2352 x 1568 pixels:
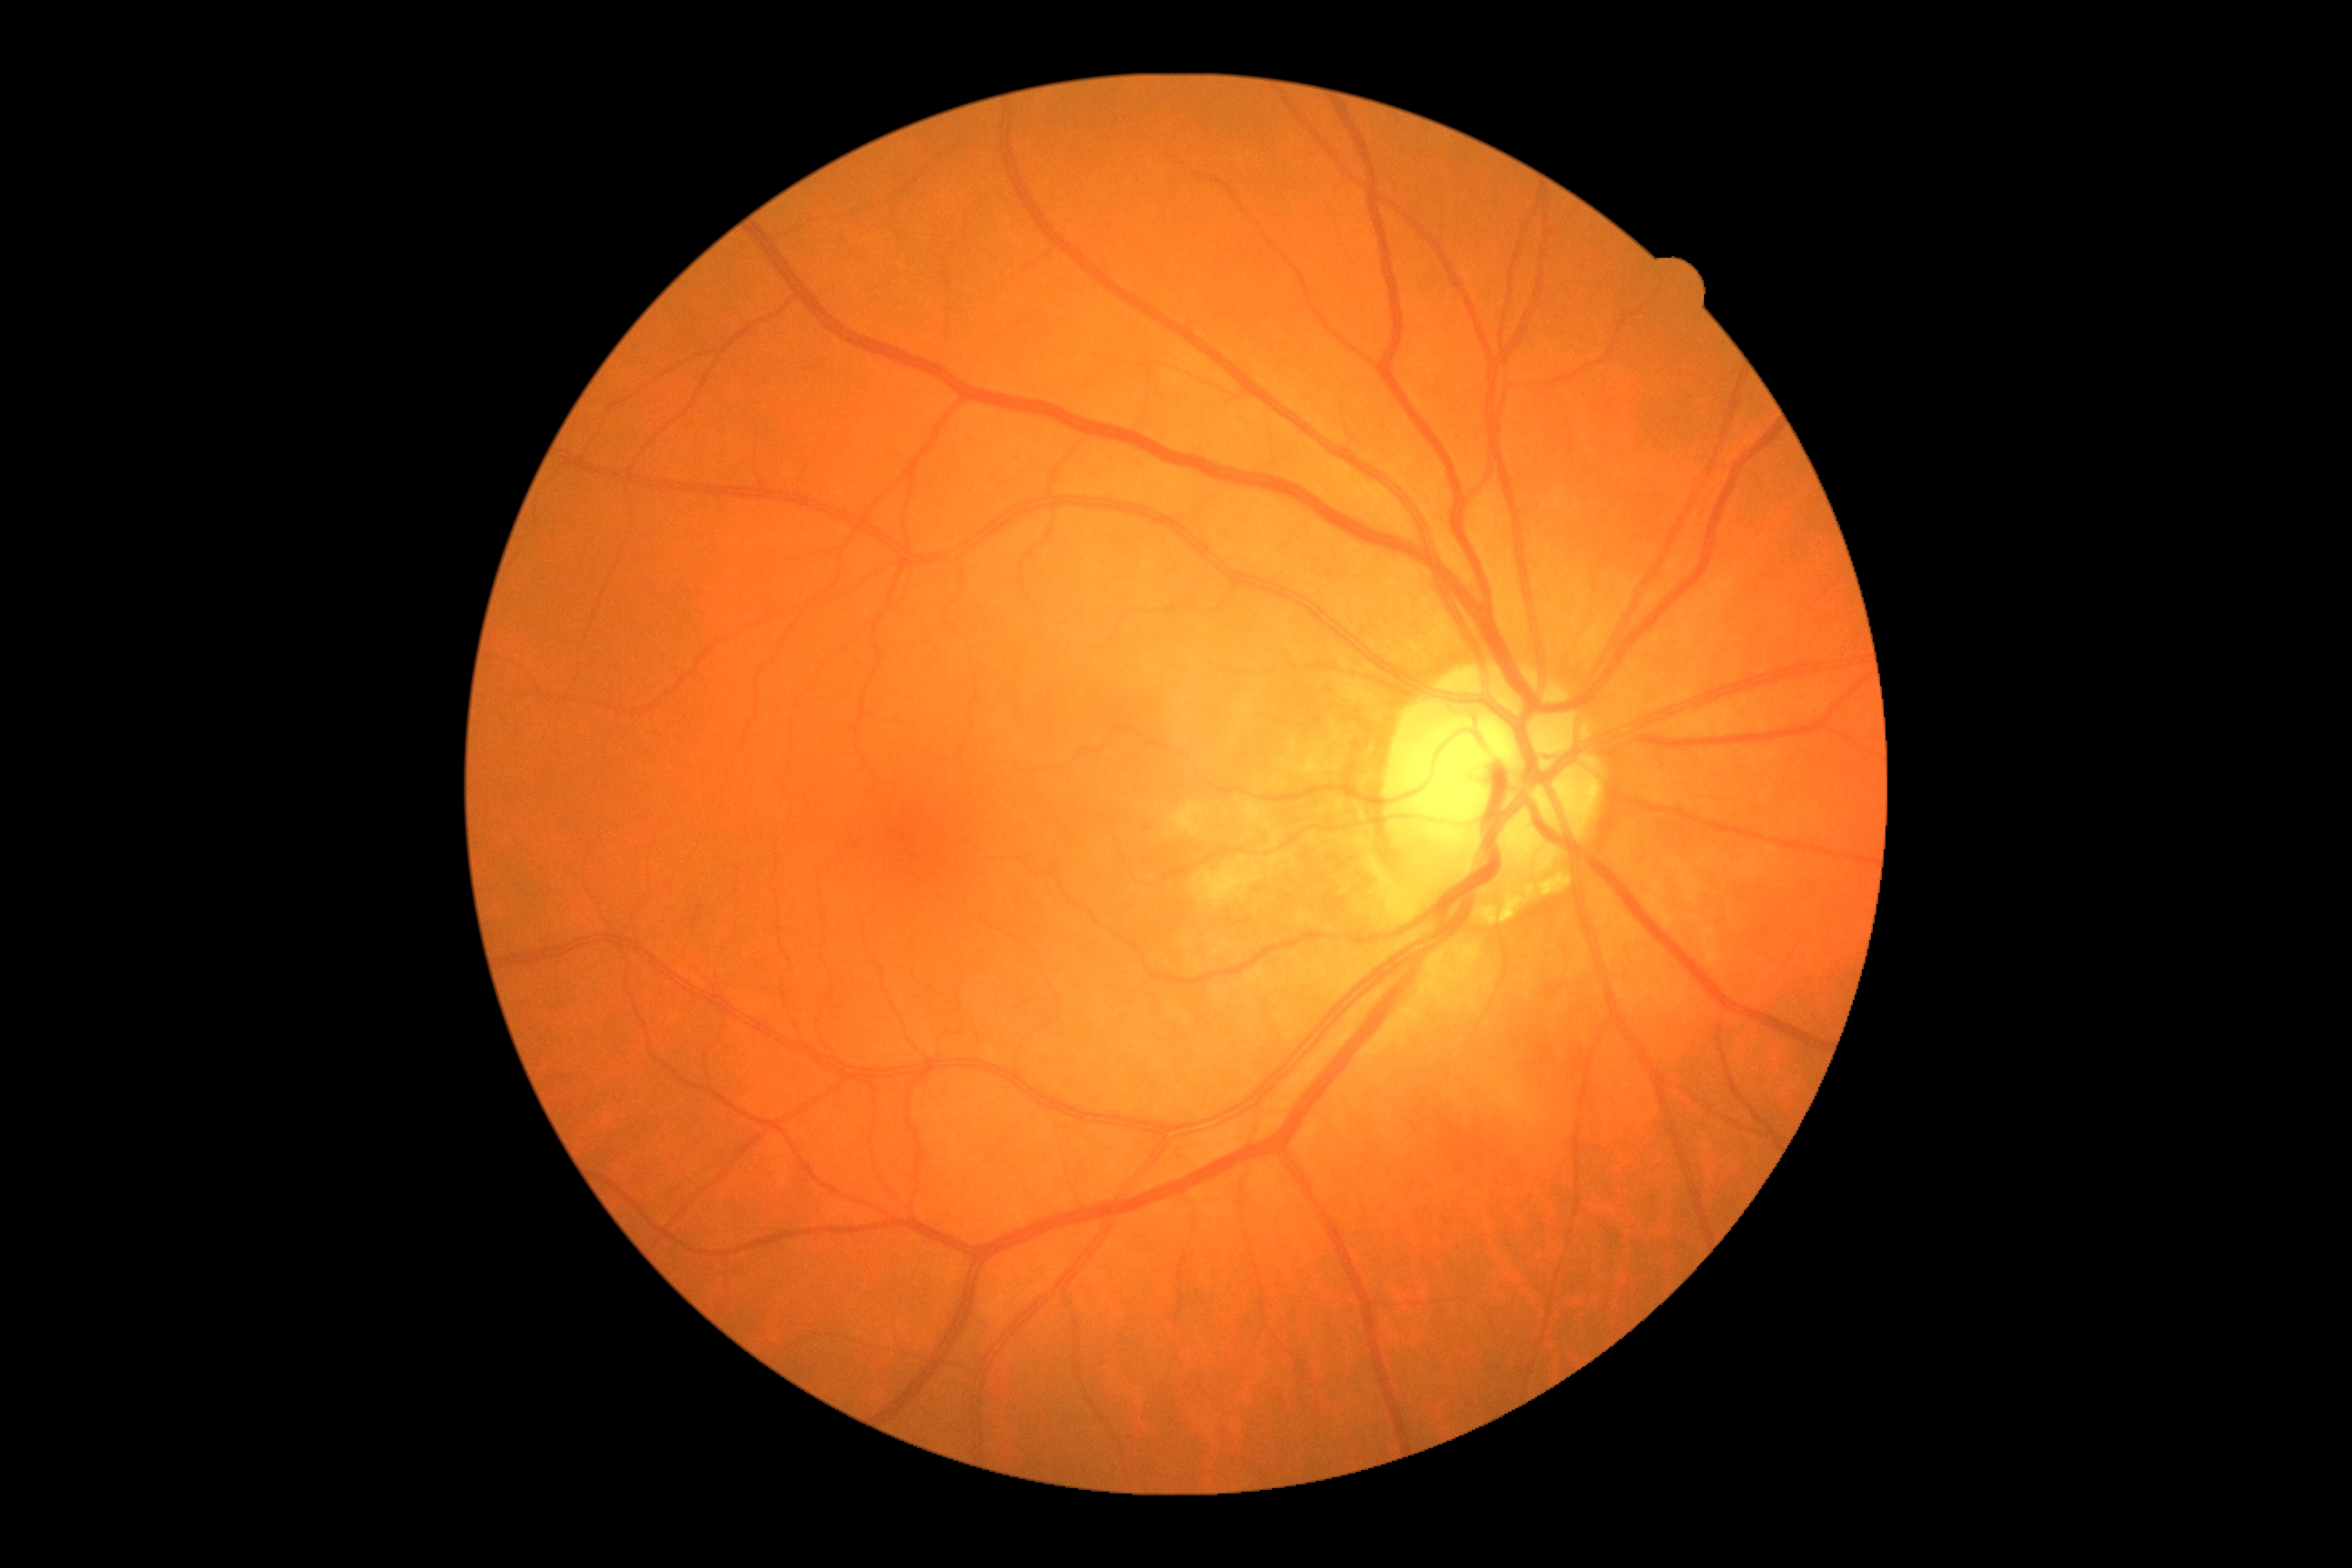
DR is no apparent diabetic retinopathy (grade 0).